Fundus photo, 45° FOV, 1932x1910
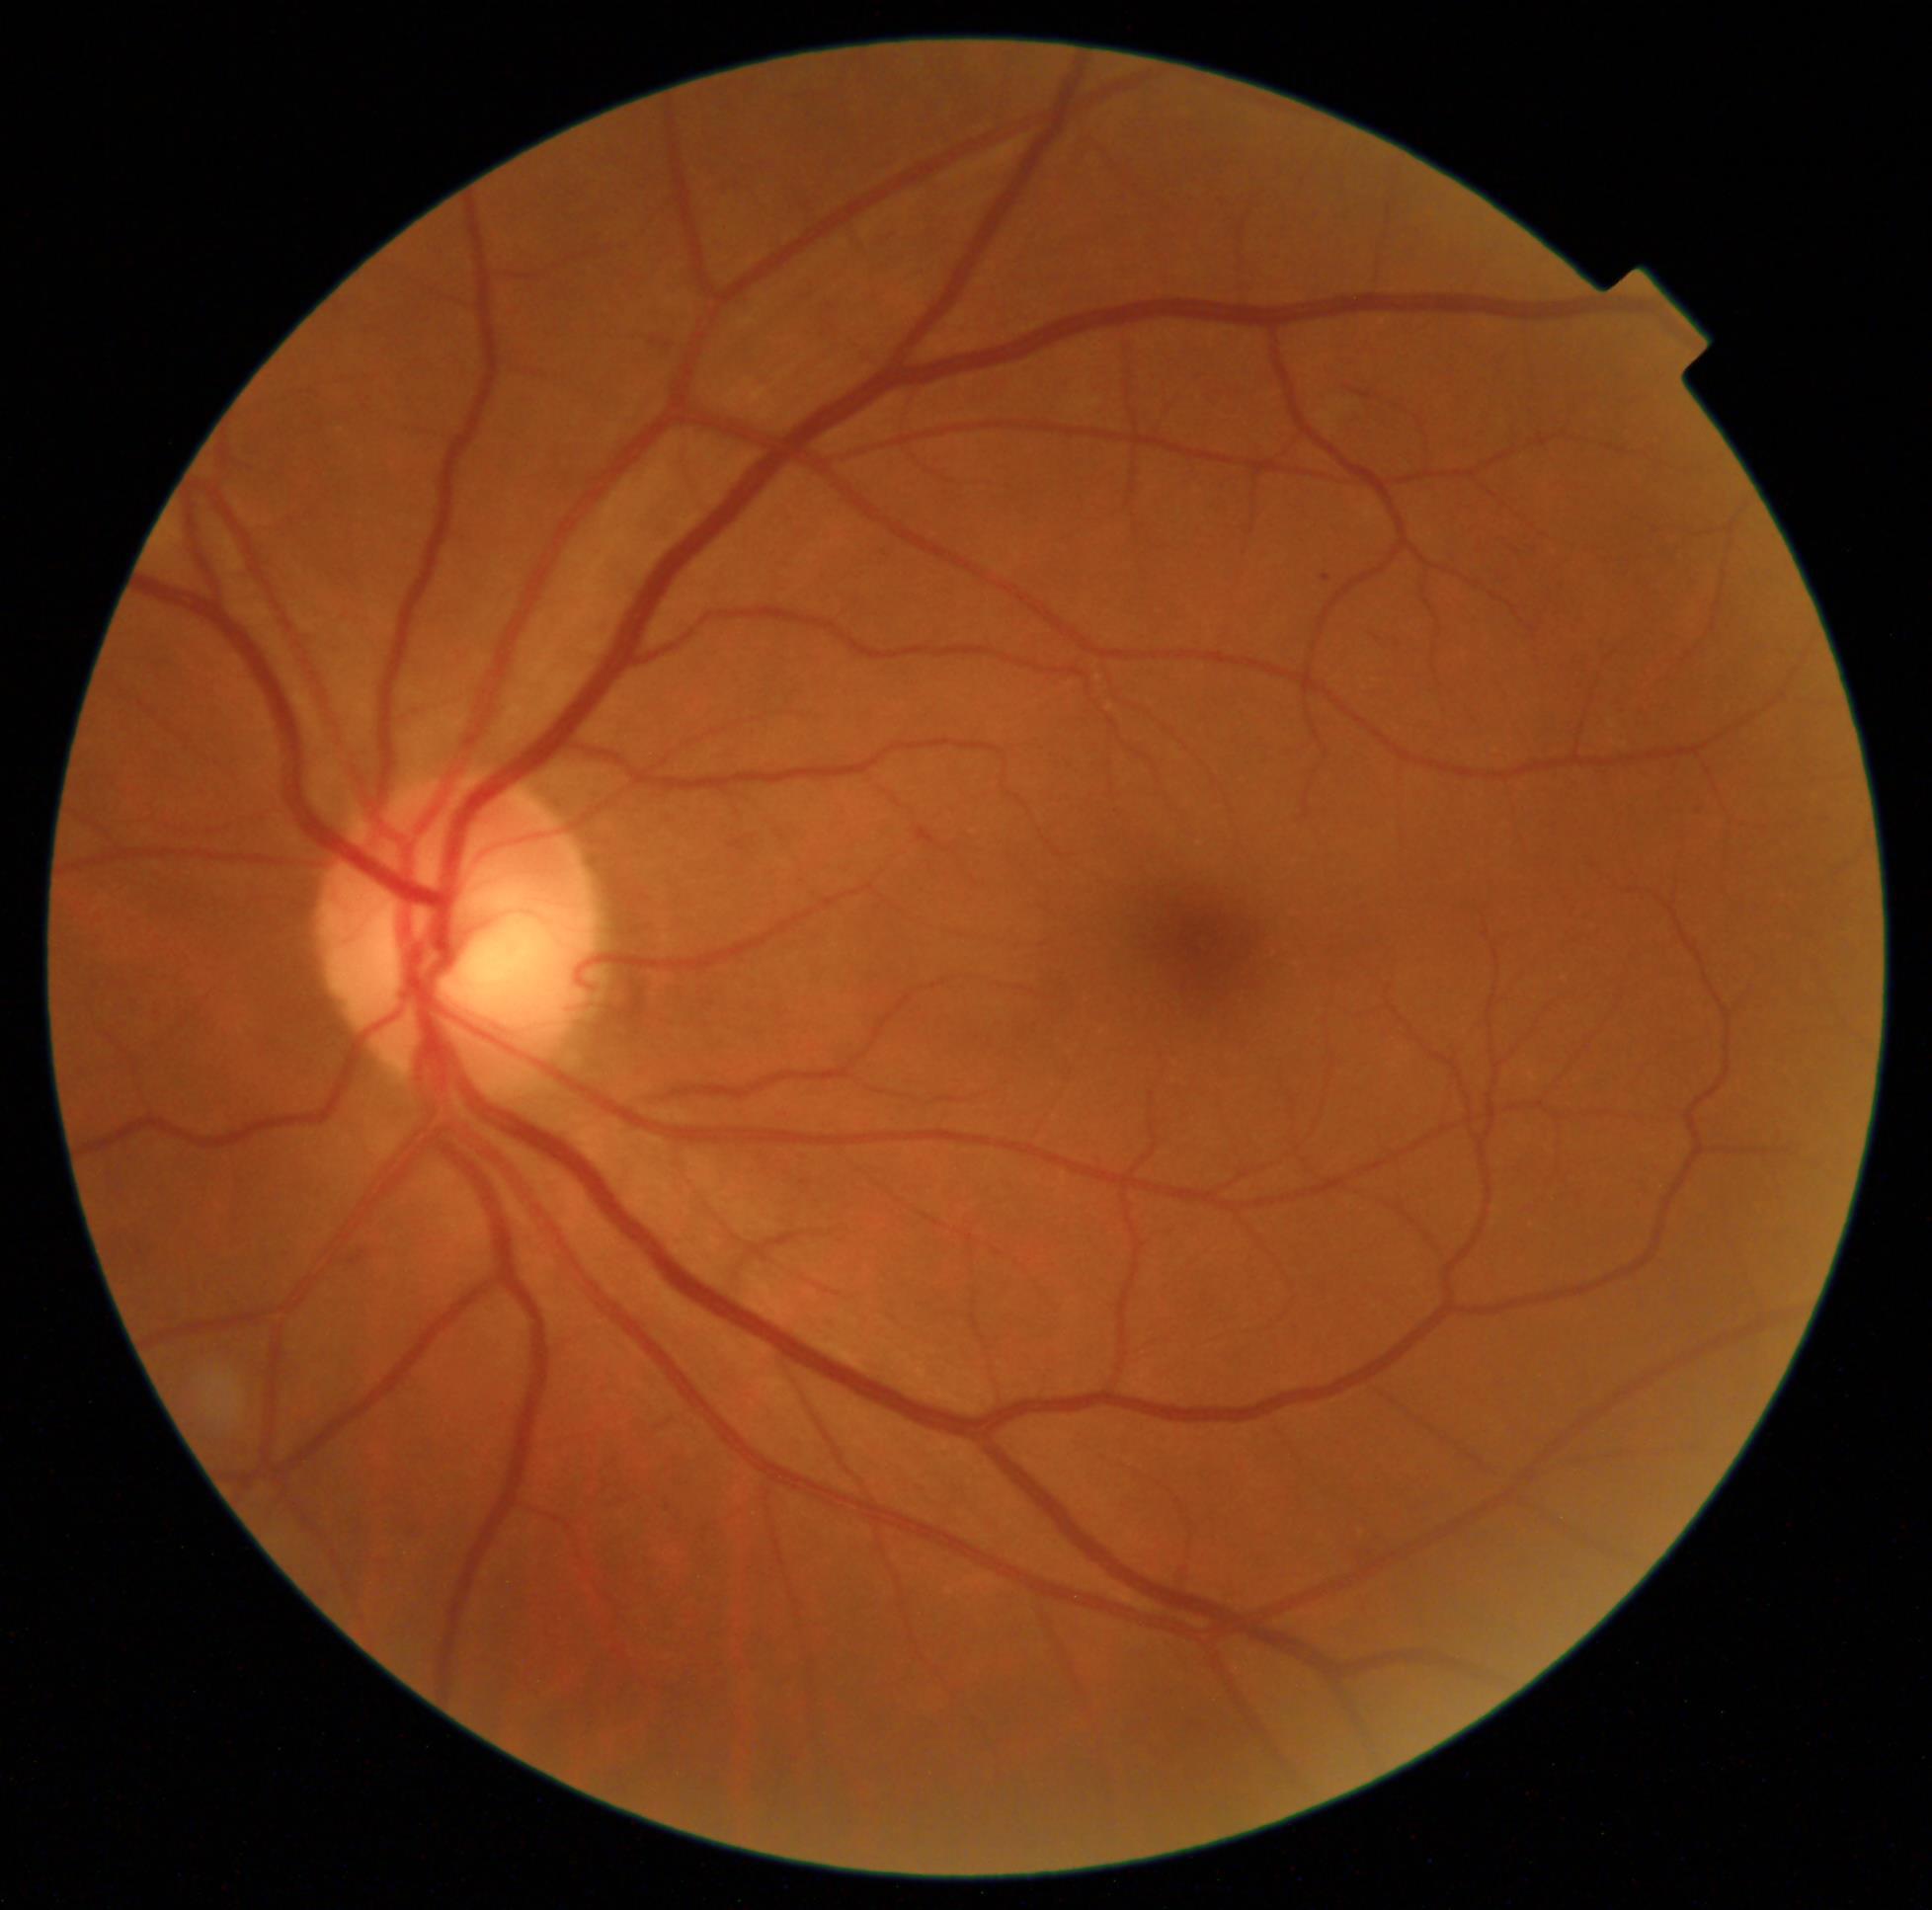 Diabetic retinopathy grade: 1.